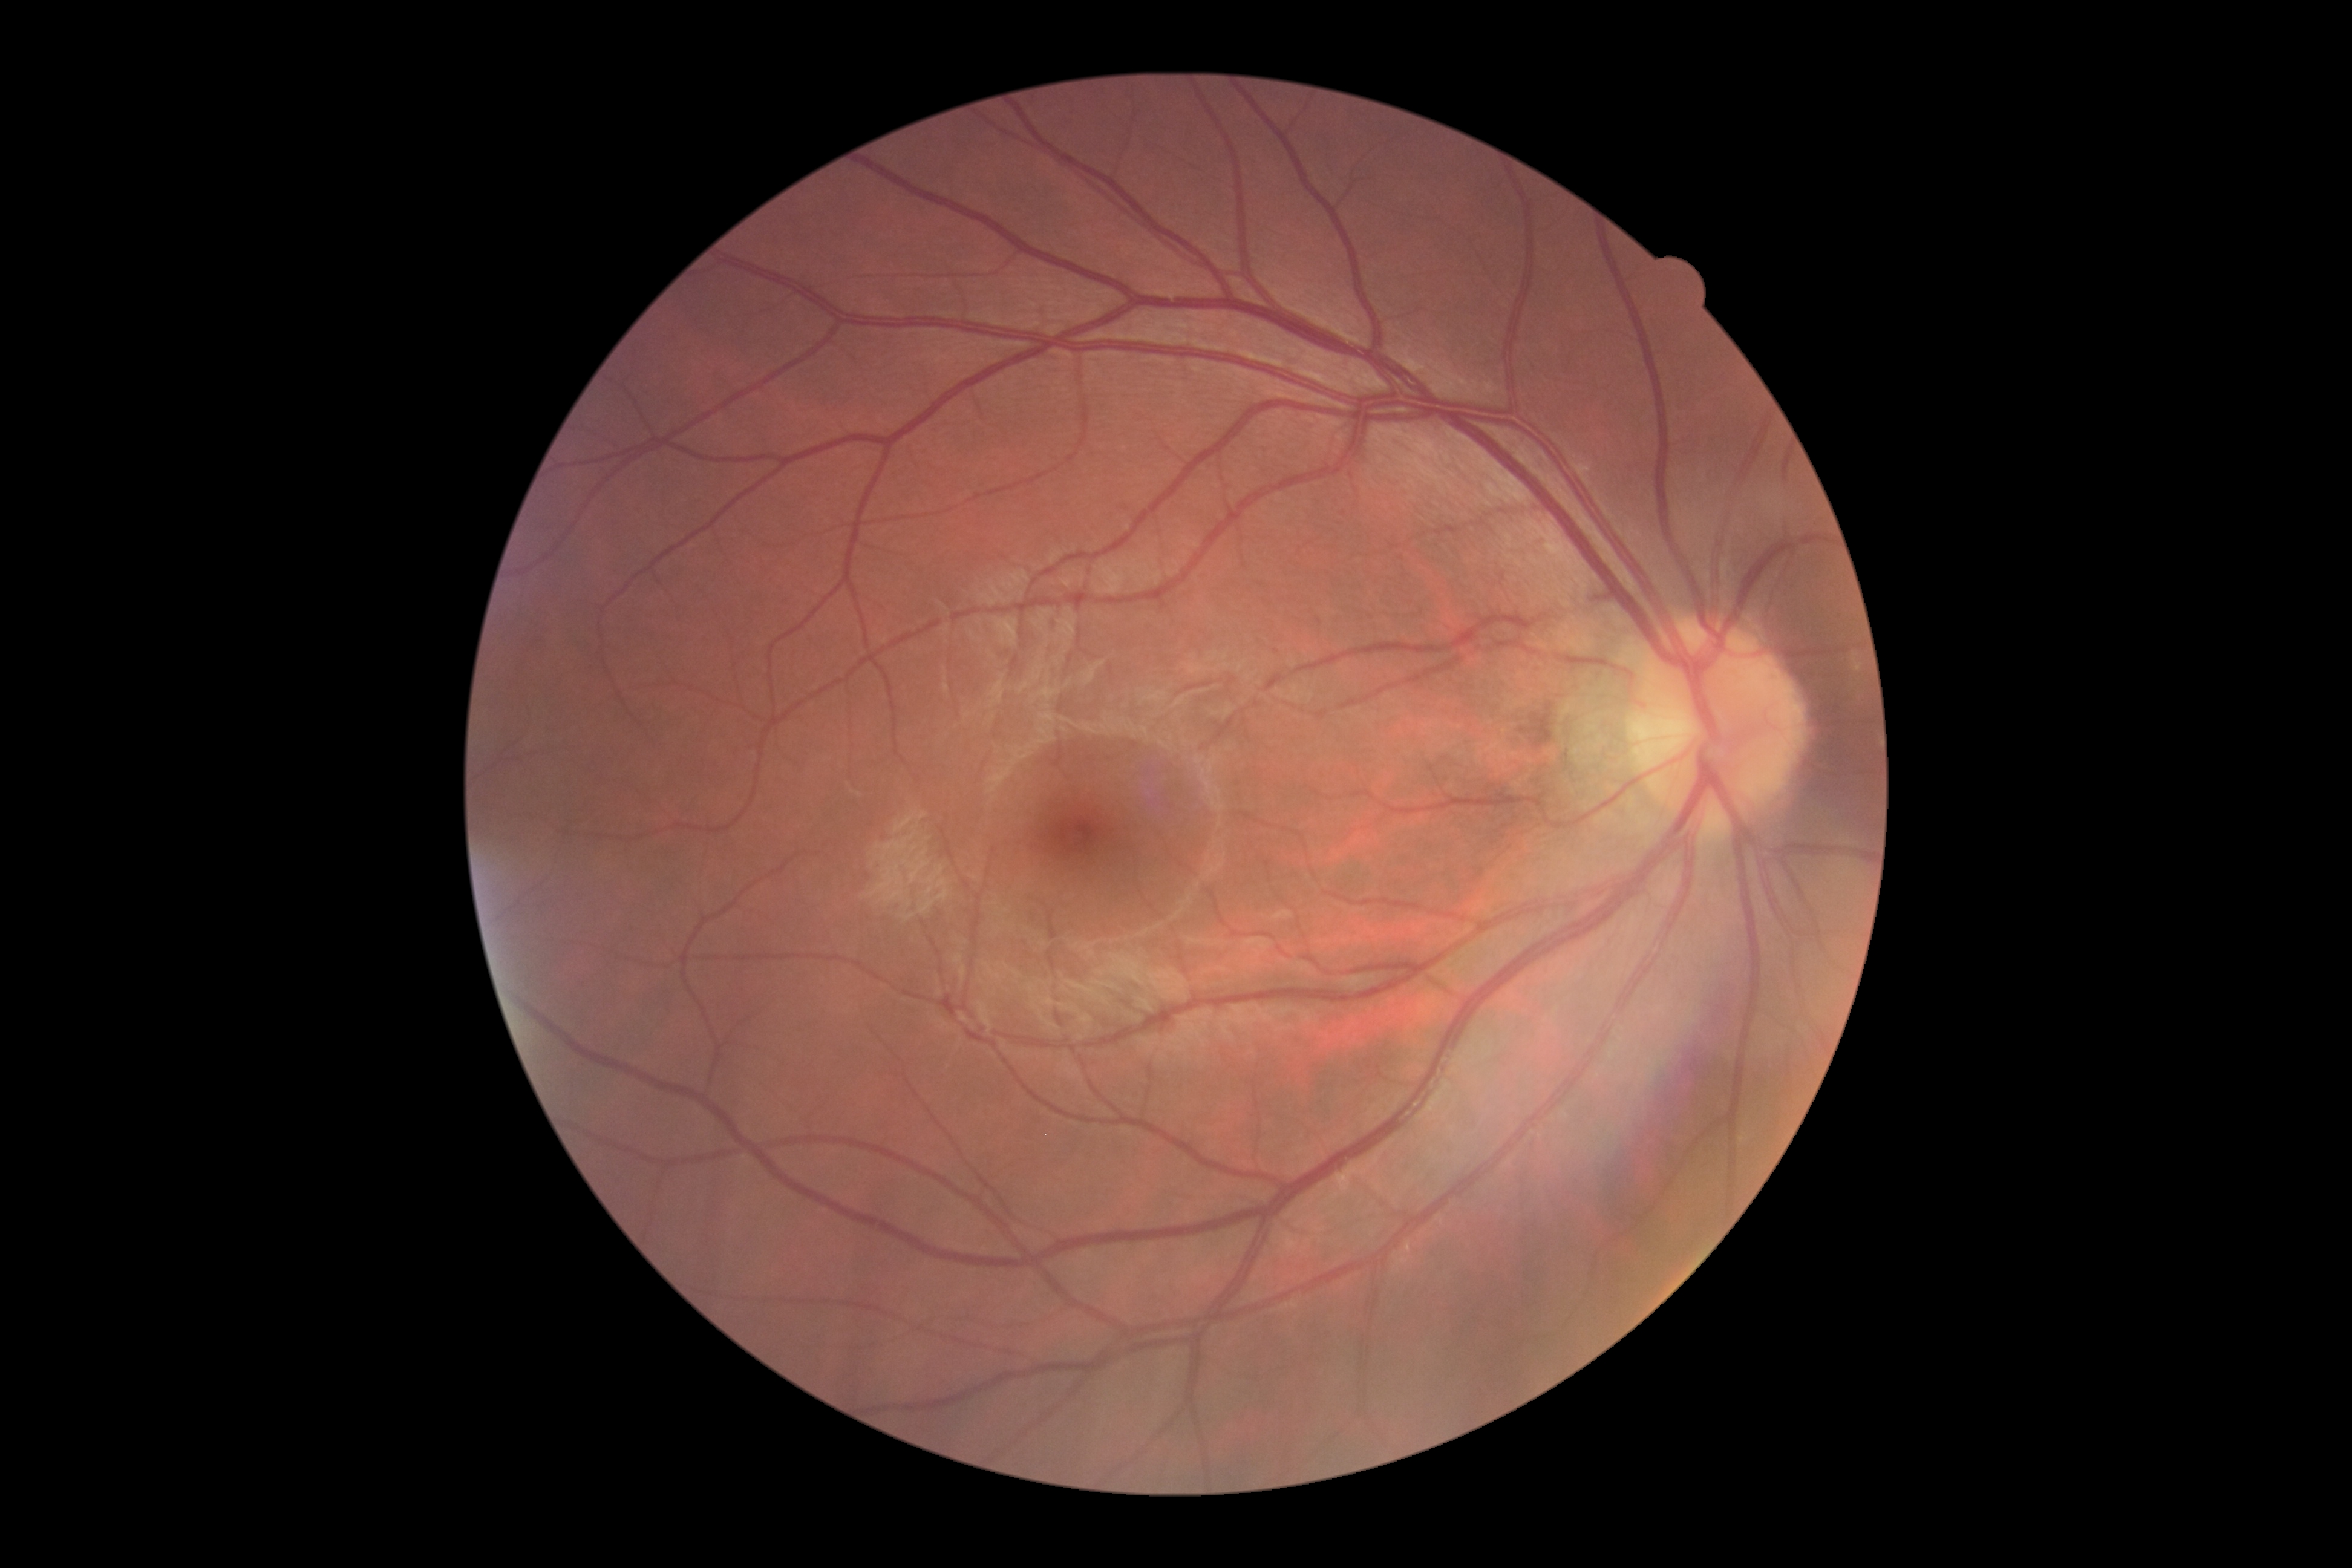
Diabetic retinopathy grade is no apparent diabetic retinopathy (0). No DR findings.